Color fundus image
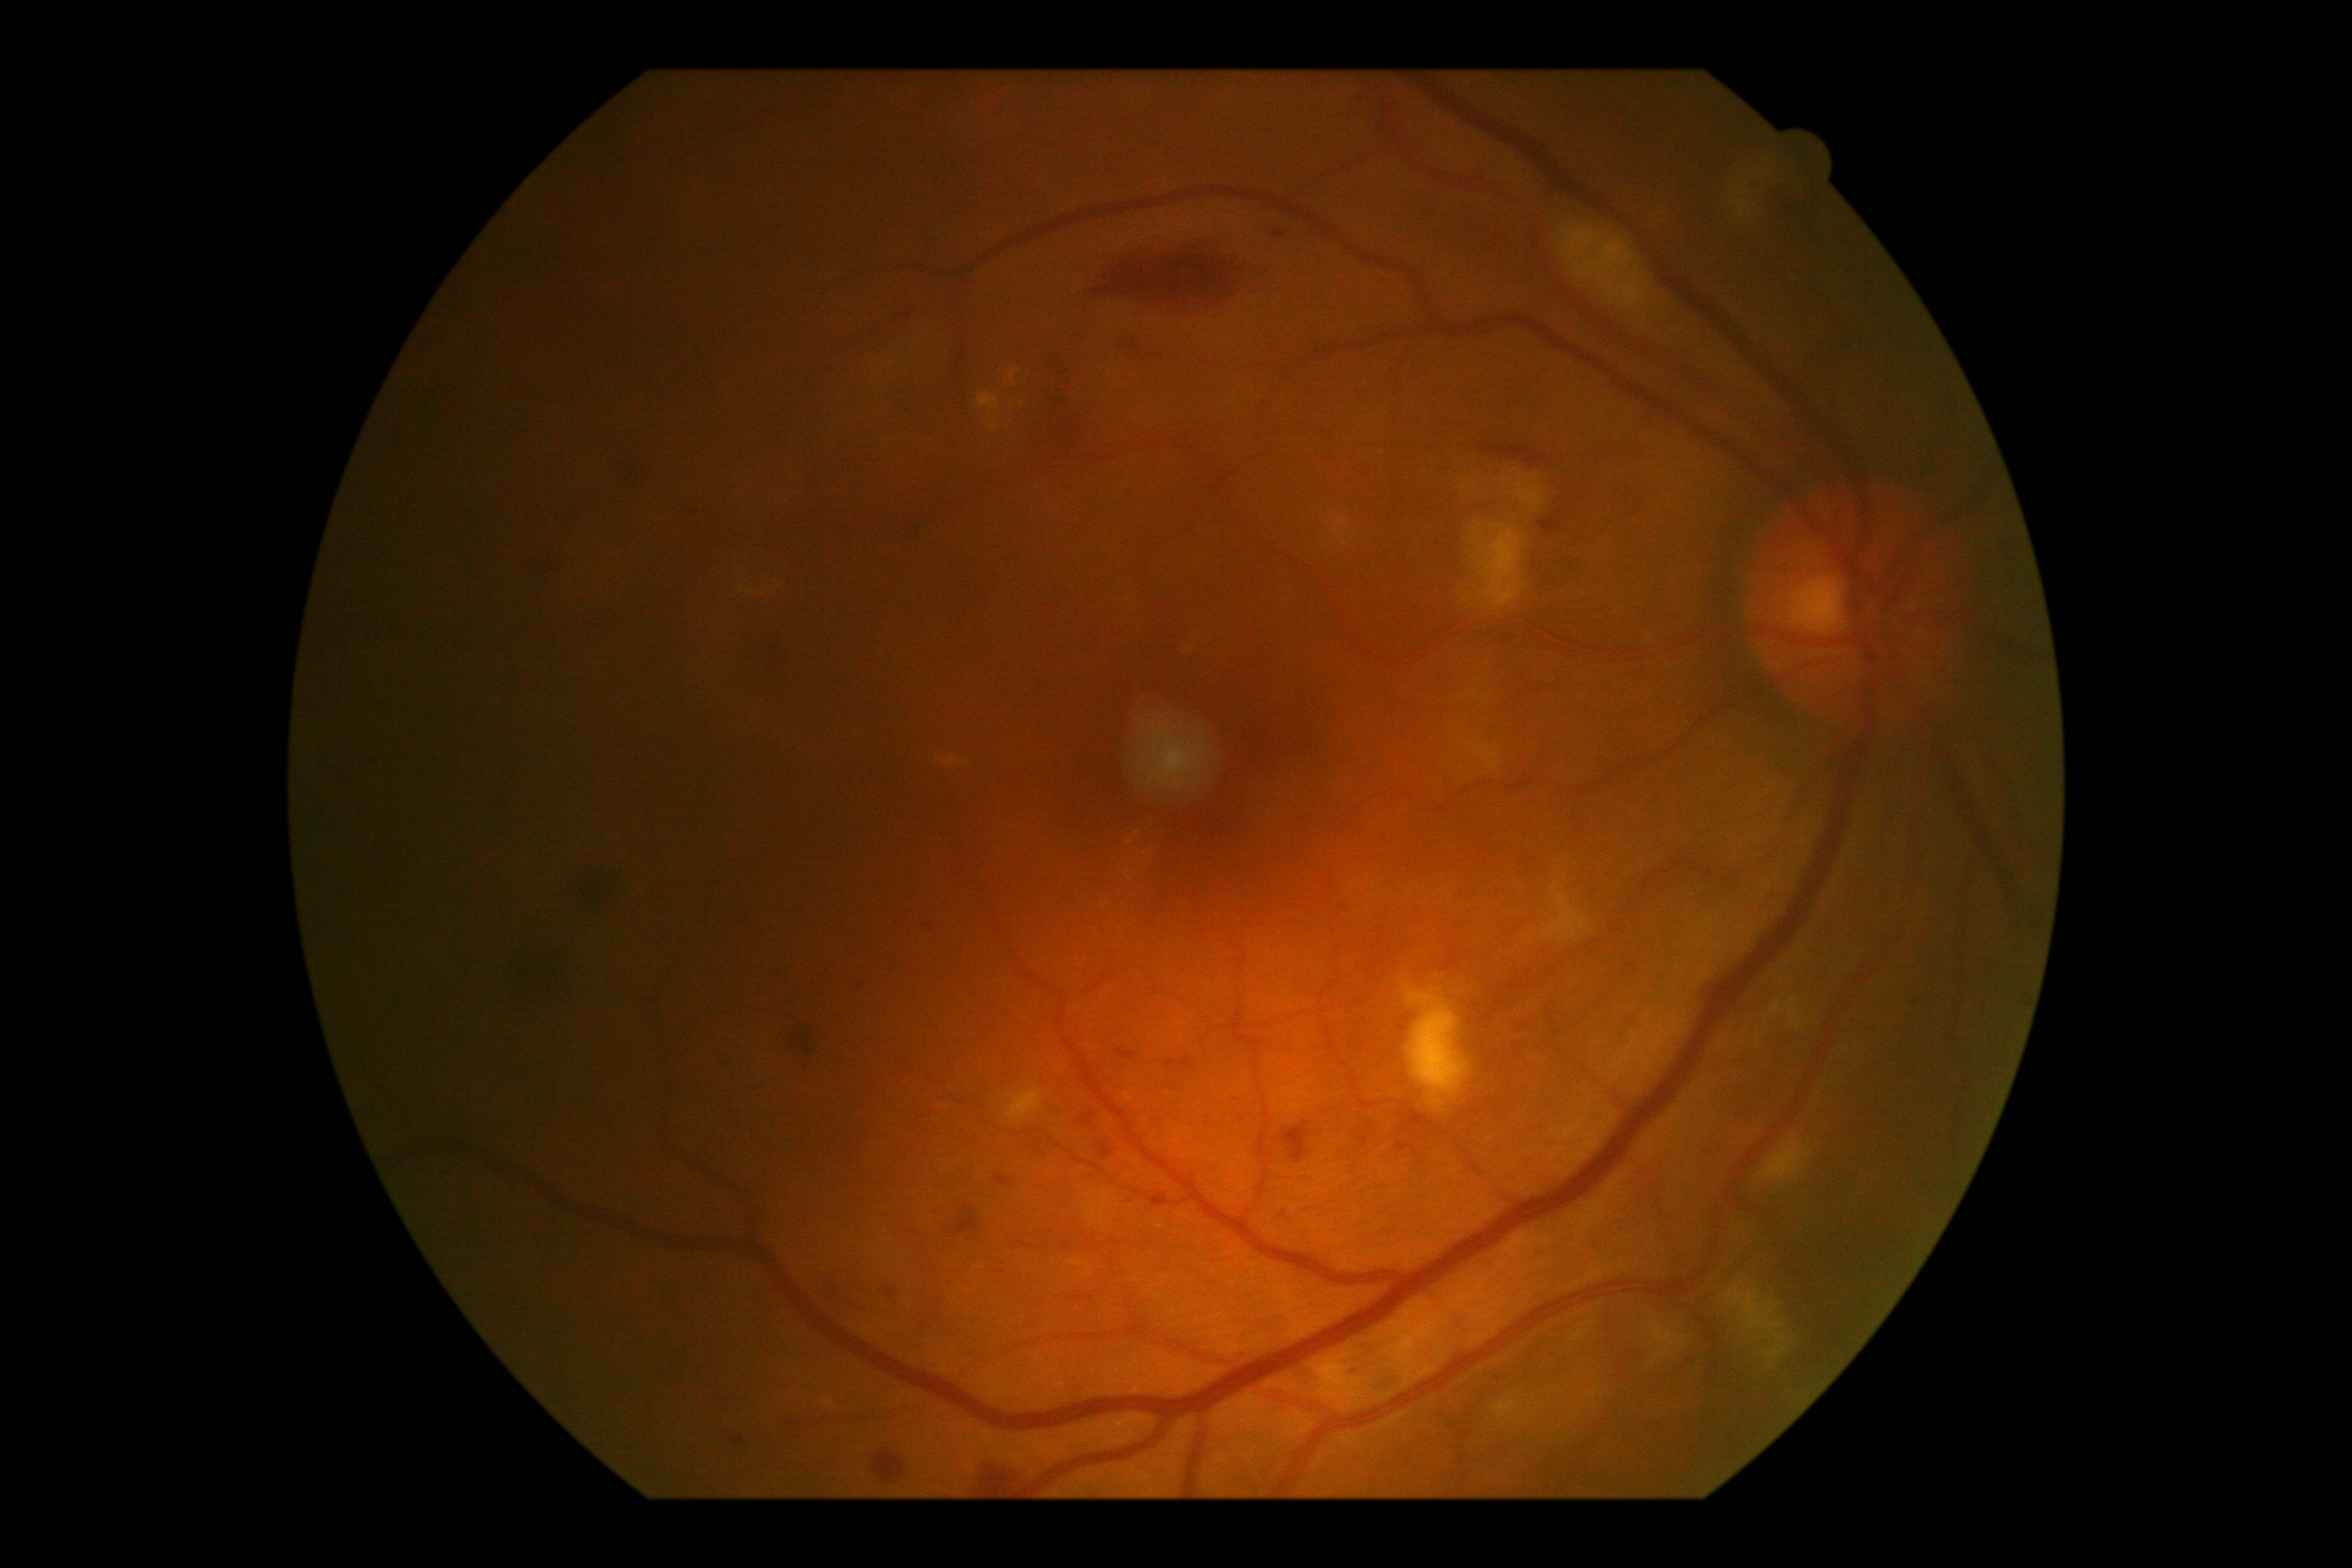
– diabetic retinopathy severity: grade 2
– DR class: non-proliferative diabetic retinopathy